Pediatric wide-field fundus photograph · 130° field of view (Natus RetCam Envision):
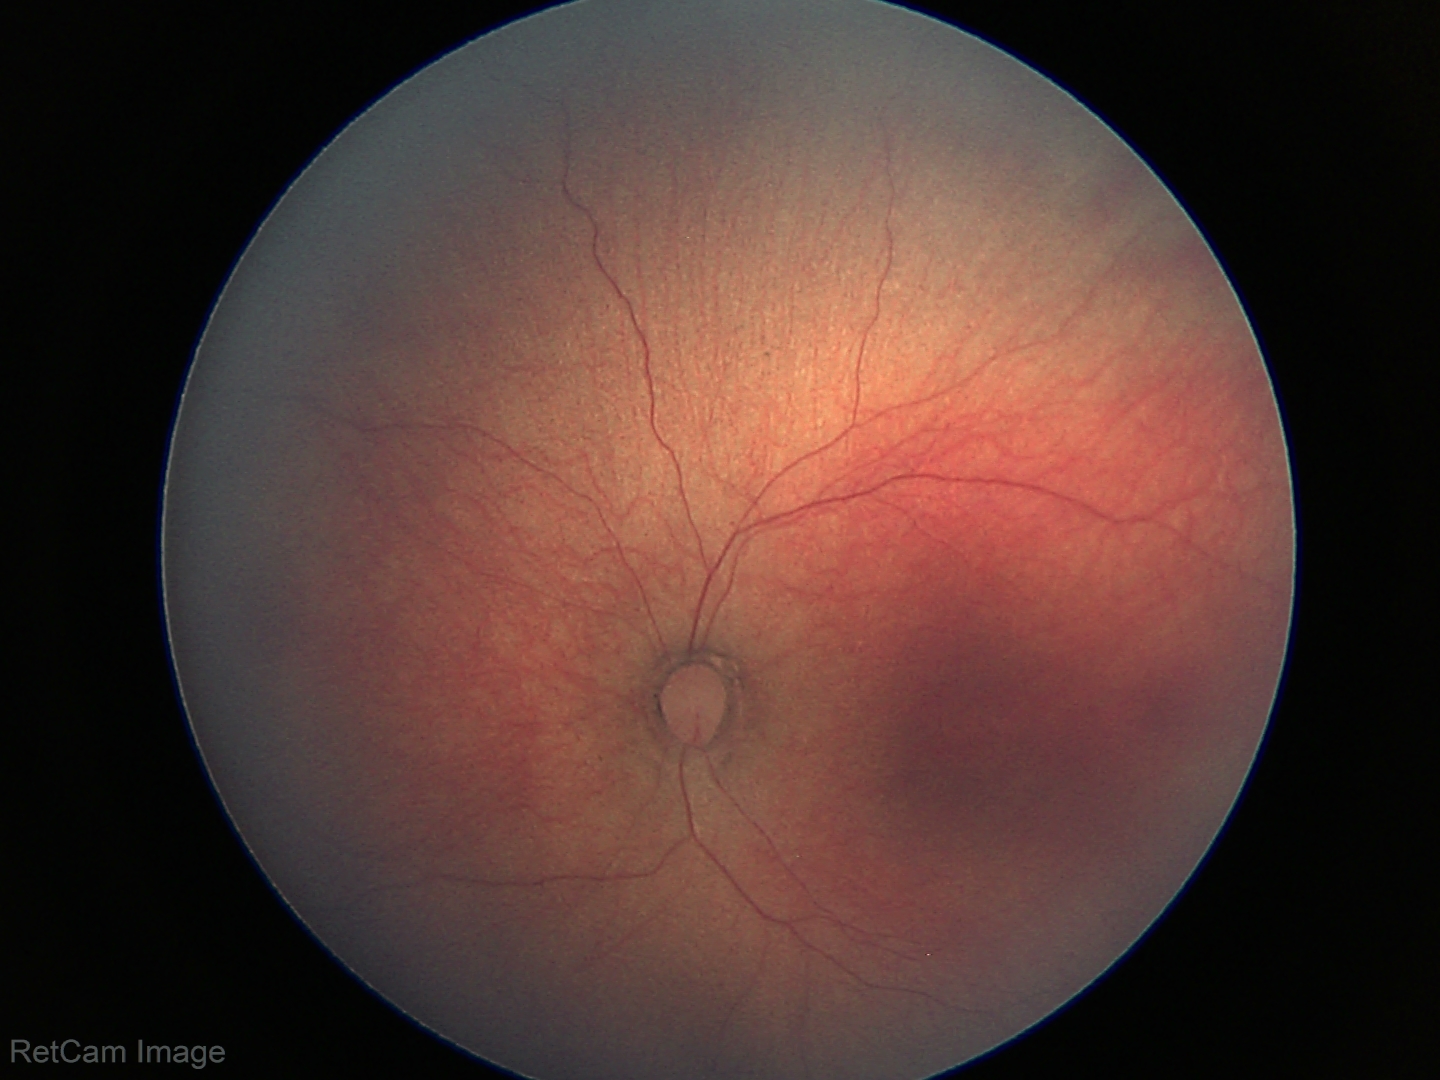

Screening examination diagnosed as physiological.